45° field of view.
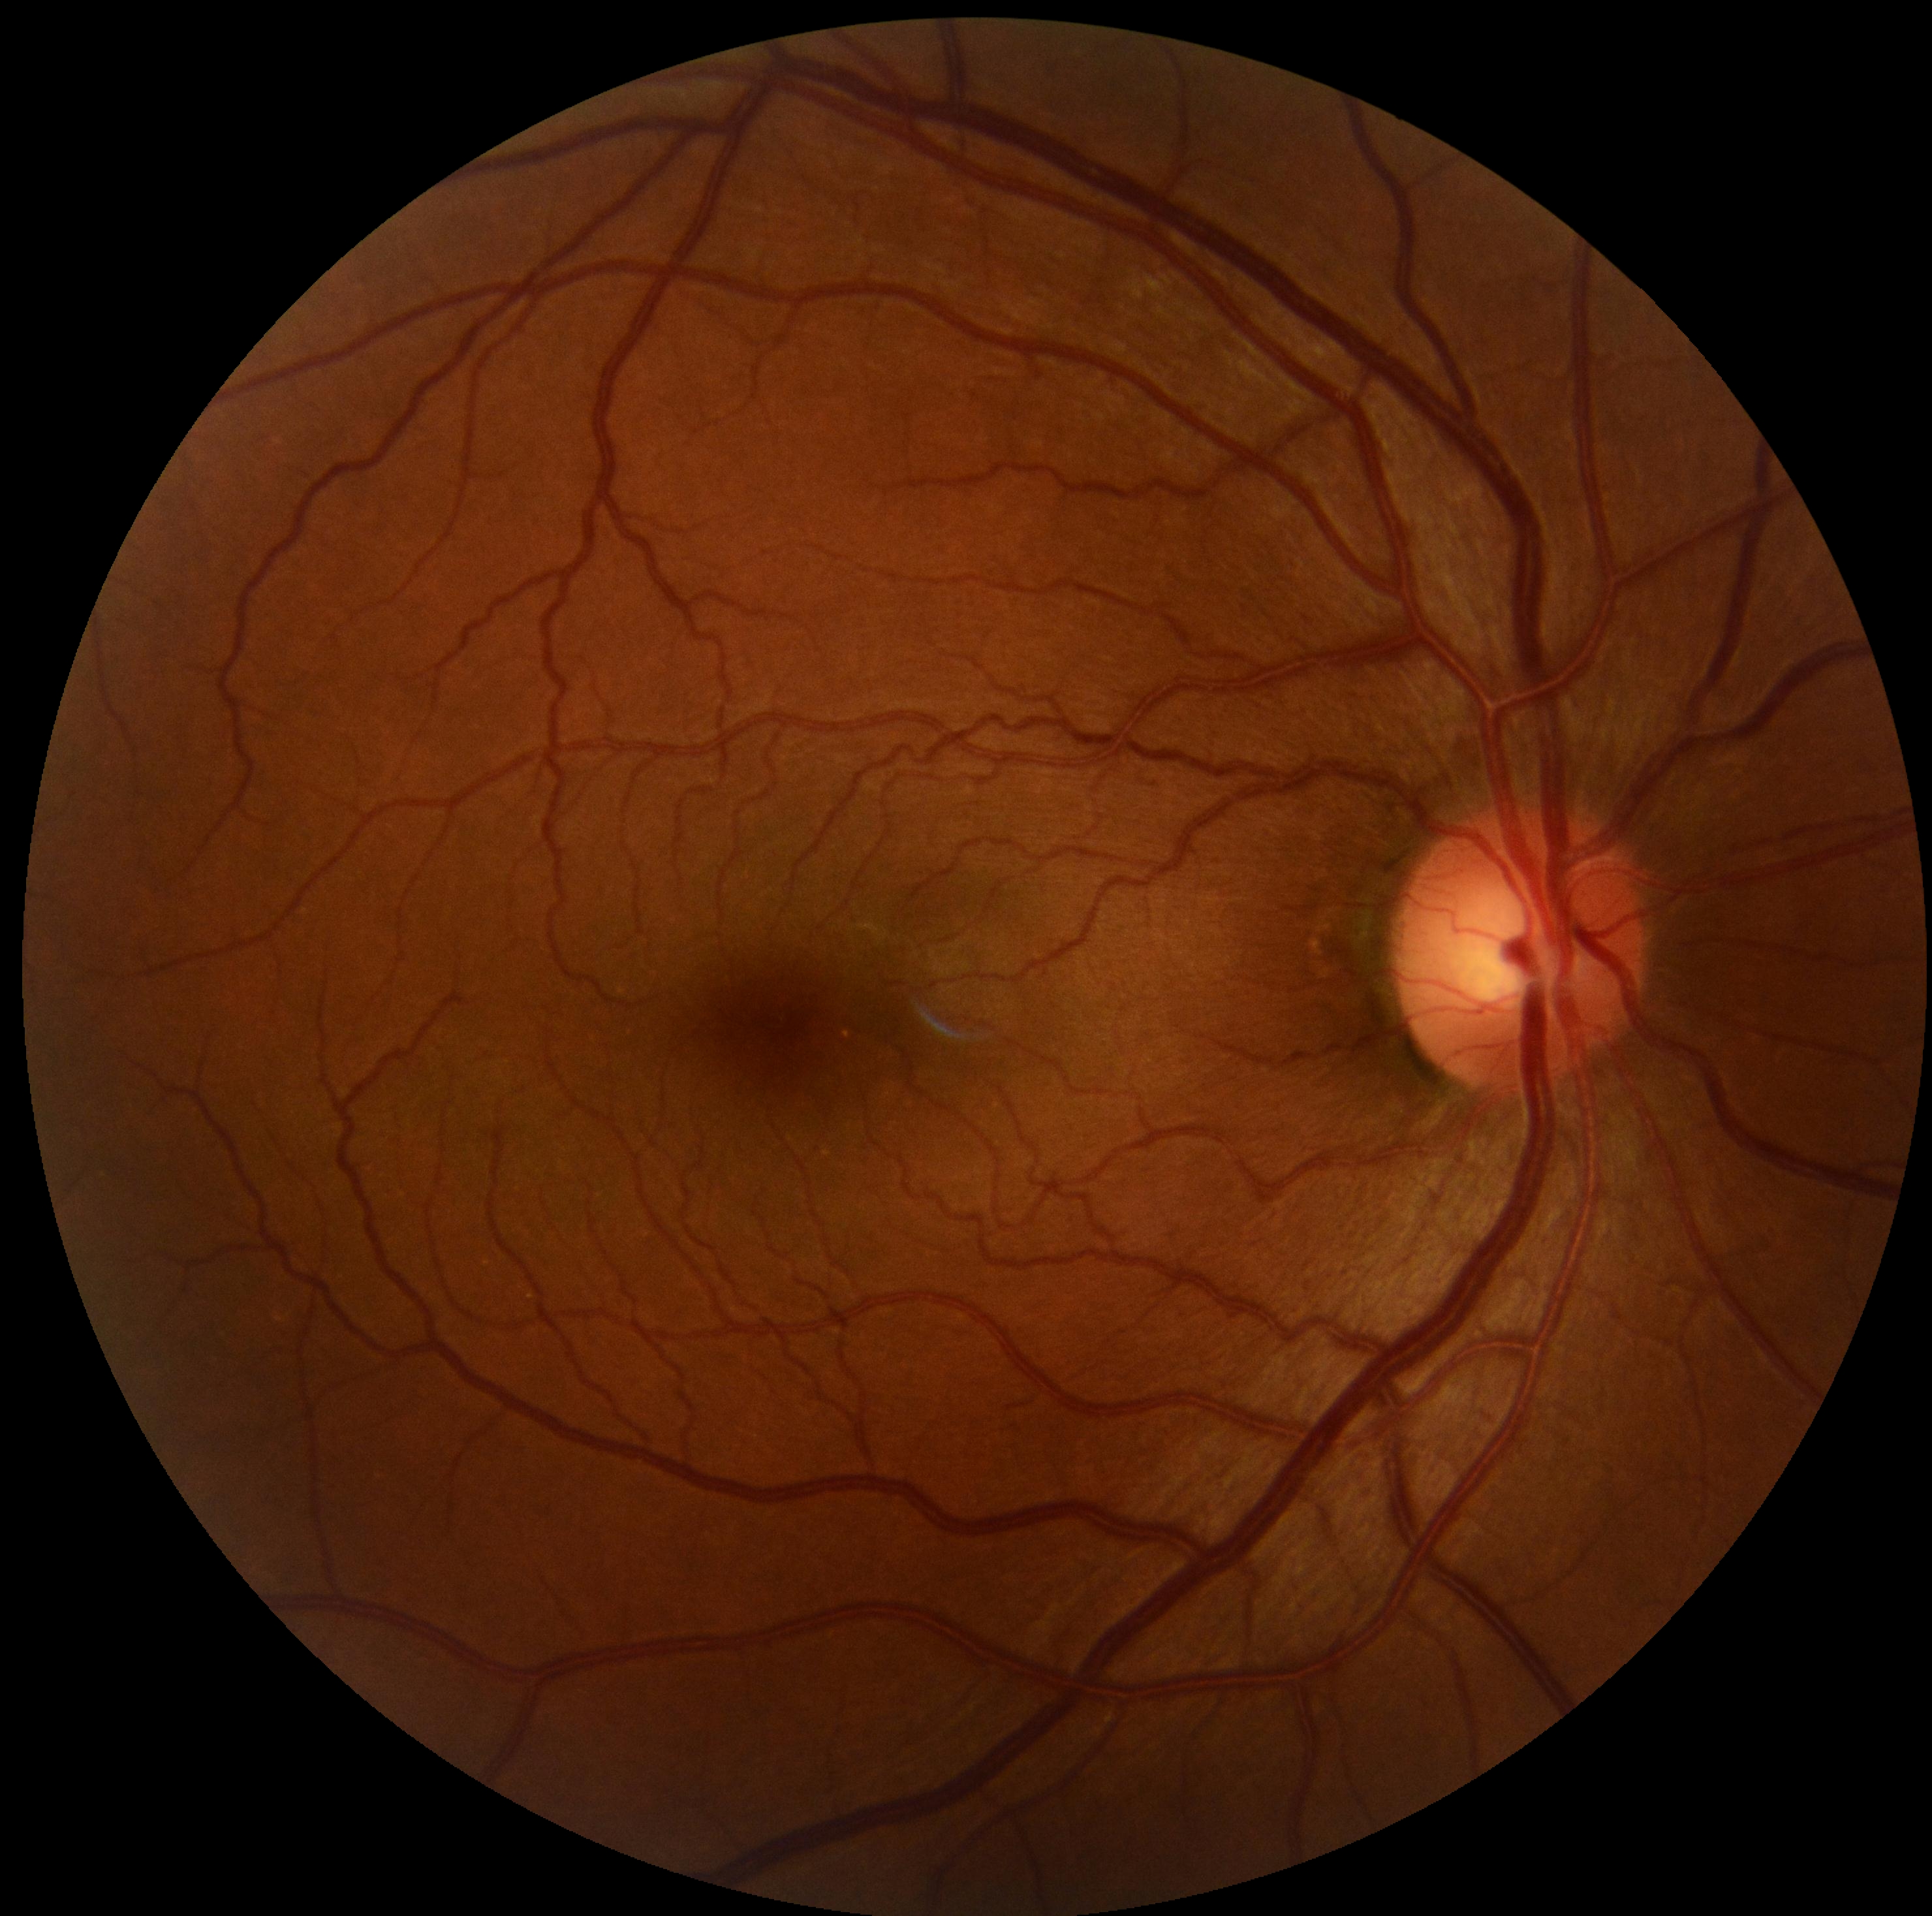
DR stage is no apparent retinopathy (grade 0).
No DR findings.